Fundus photo.
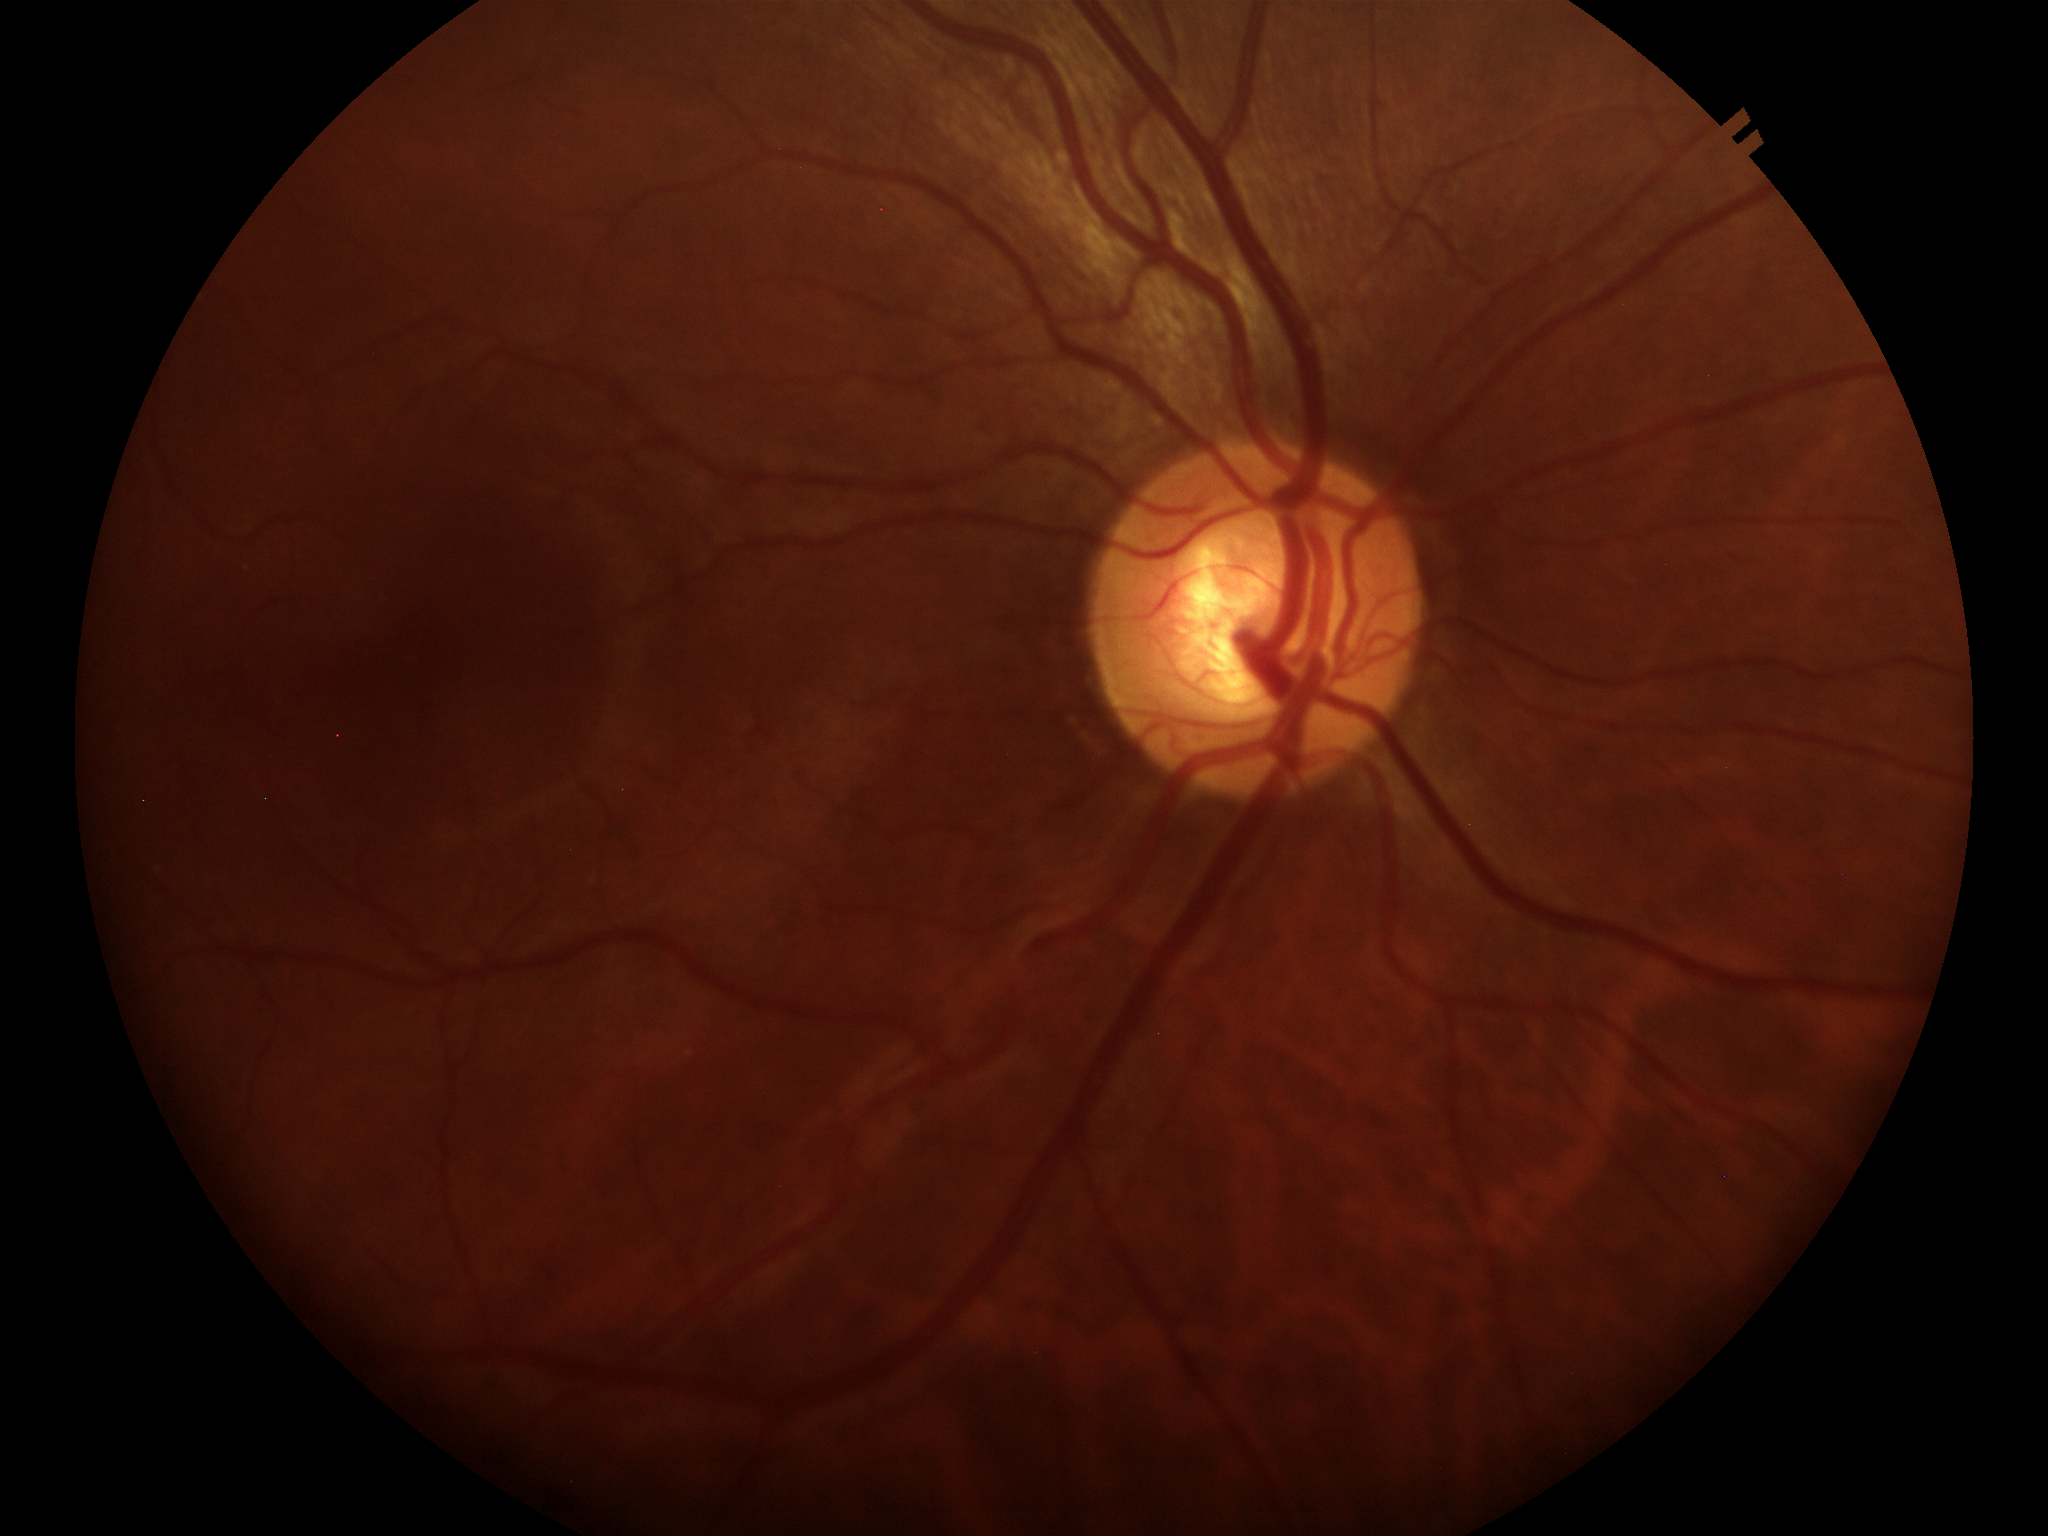

No evidence of glaucoma. Area cup-disc ratio is 0.37. Vertical C/D ratio is 0.63. Horizontal cup-to-disc ratio of 0.59.